No pharmacologic dilation · acquired with a NIDEK AFC-230
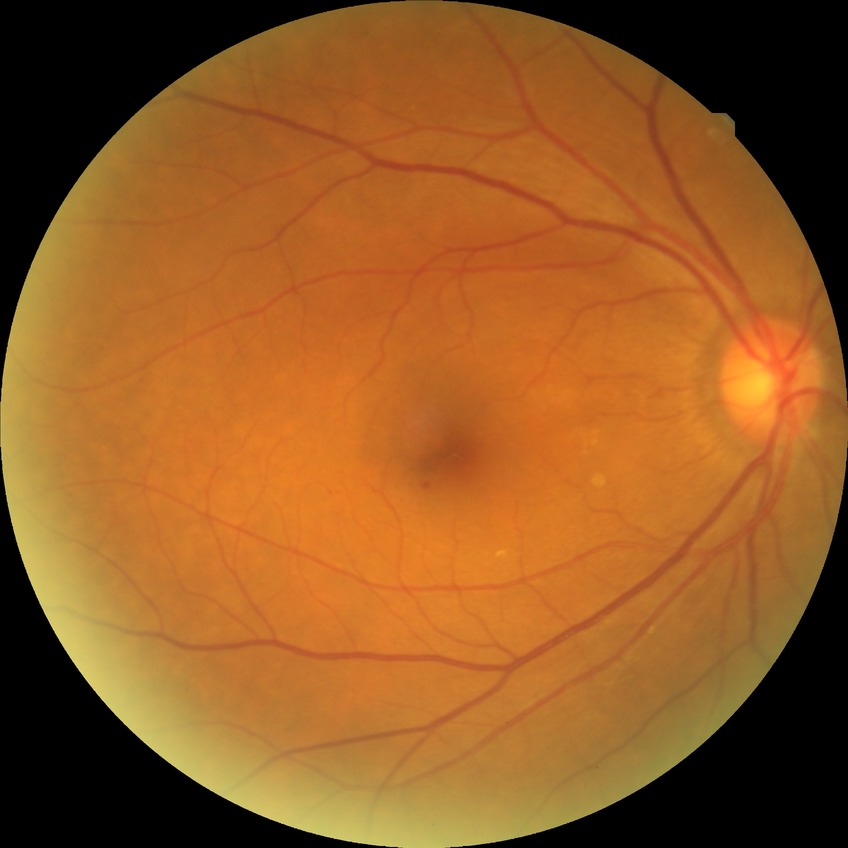

Modified Davis grading is simple diabetic retinopathy.